Color fundus image; 848x848px; FOV: 45 degrees; Davis DR grading; NIDEK AFC-230; nonmydriatic fundus photograph
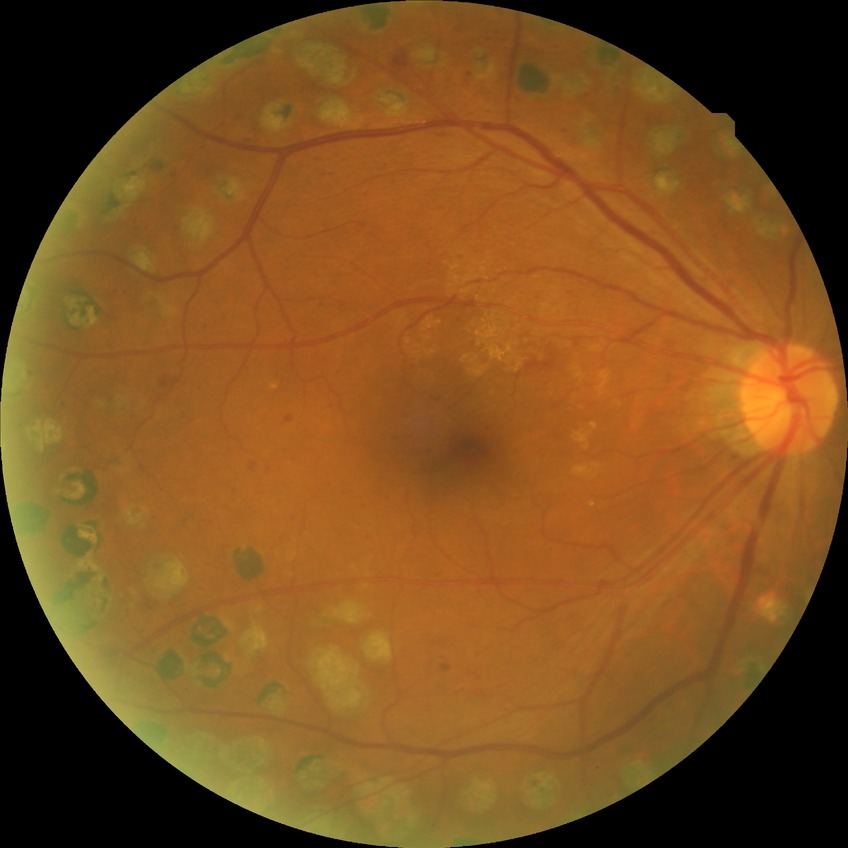

Diabetic retinopathy (DR): PDR (proliferative diabetic retinopathy).